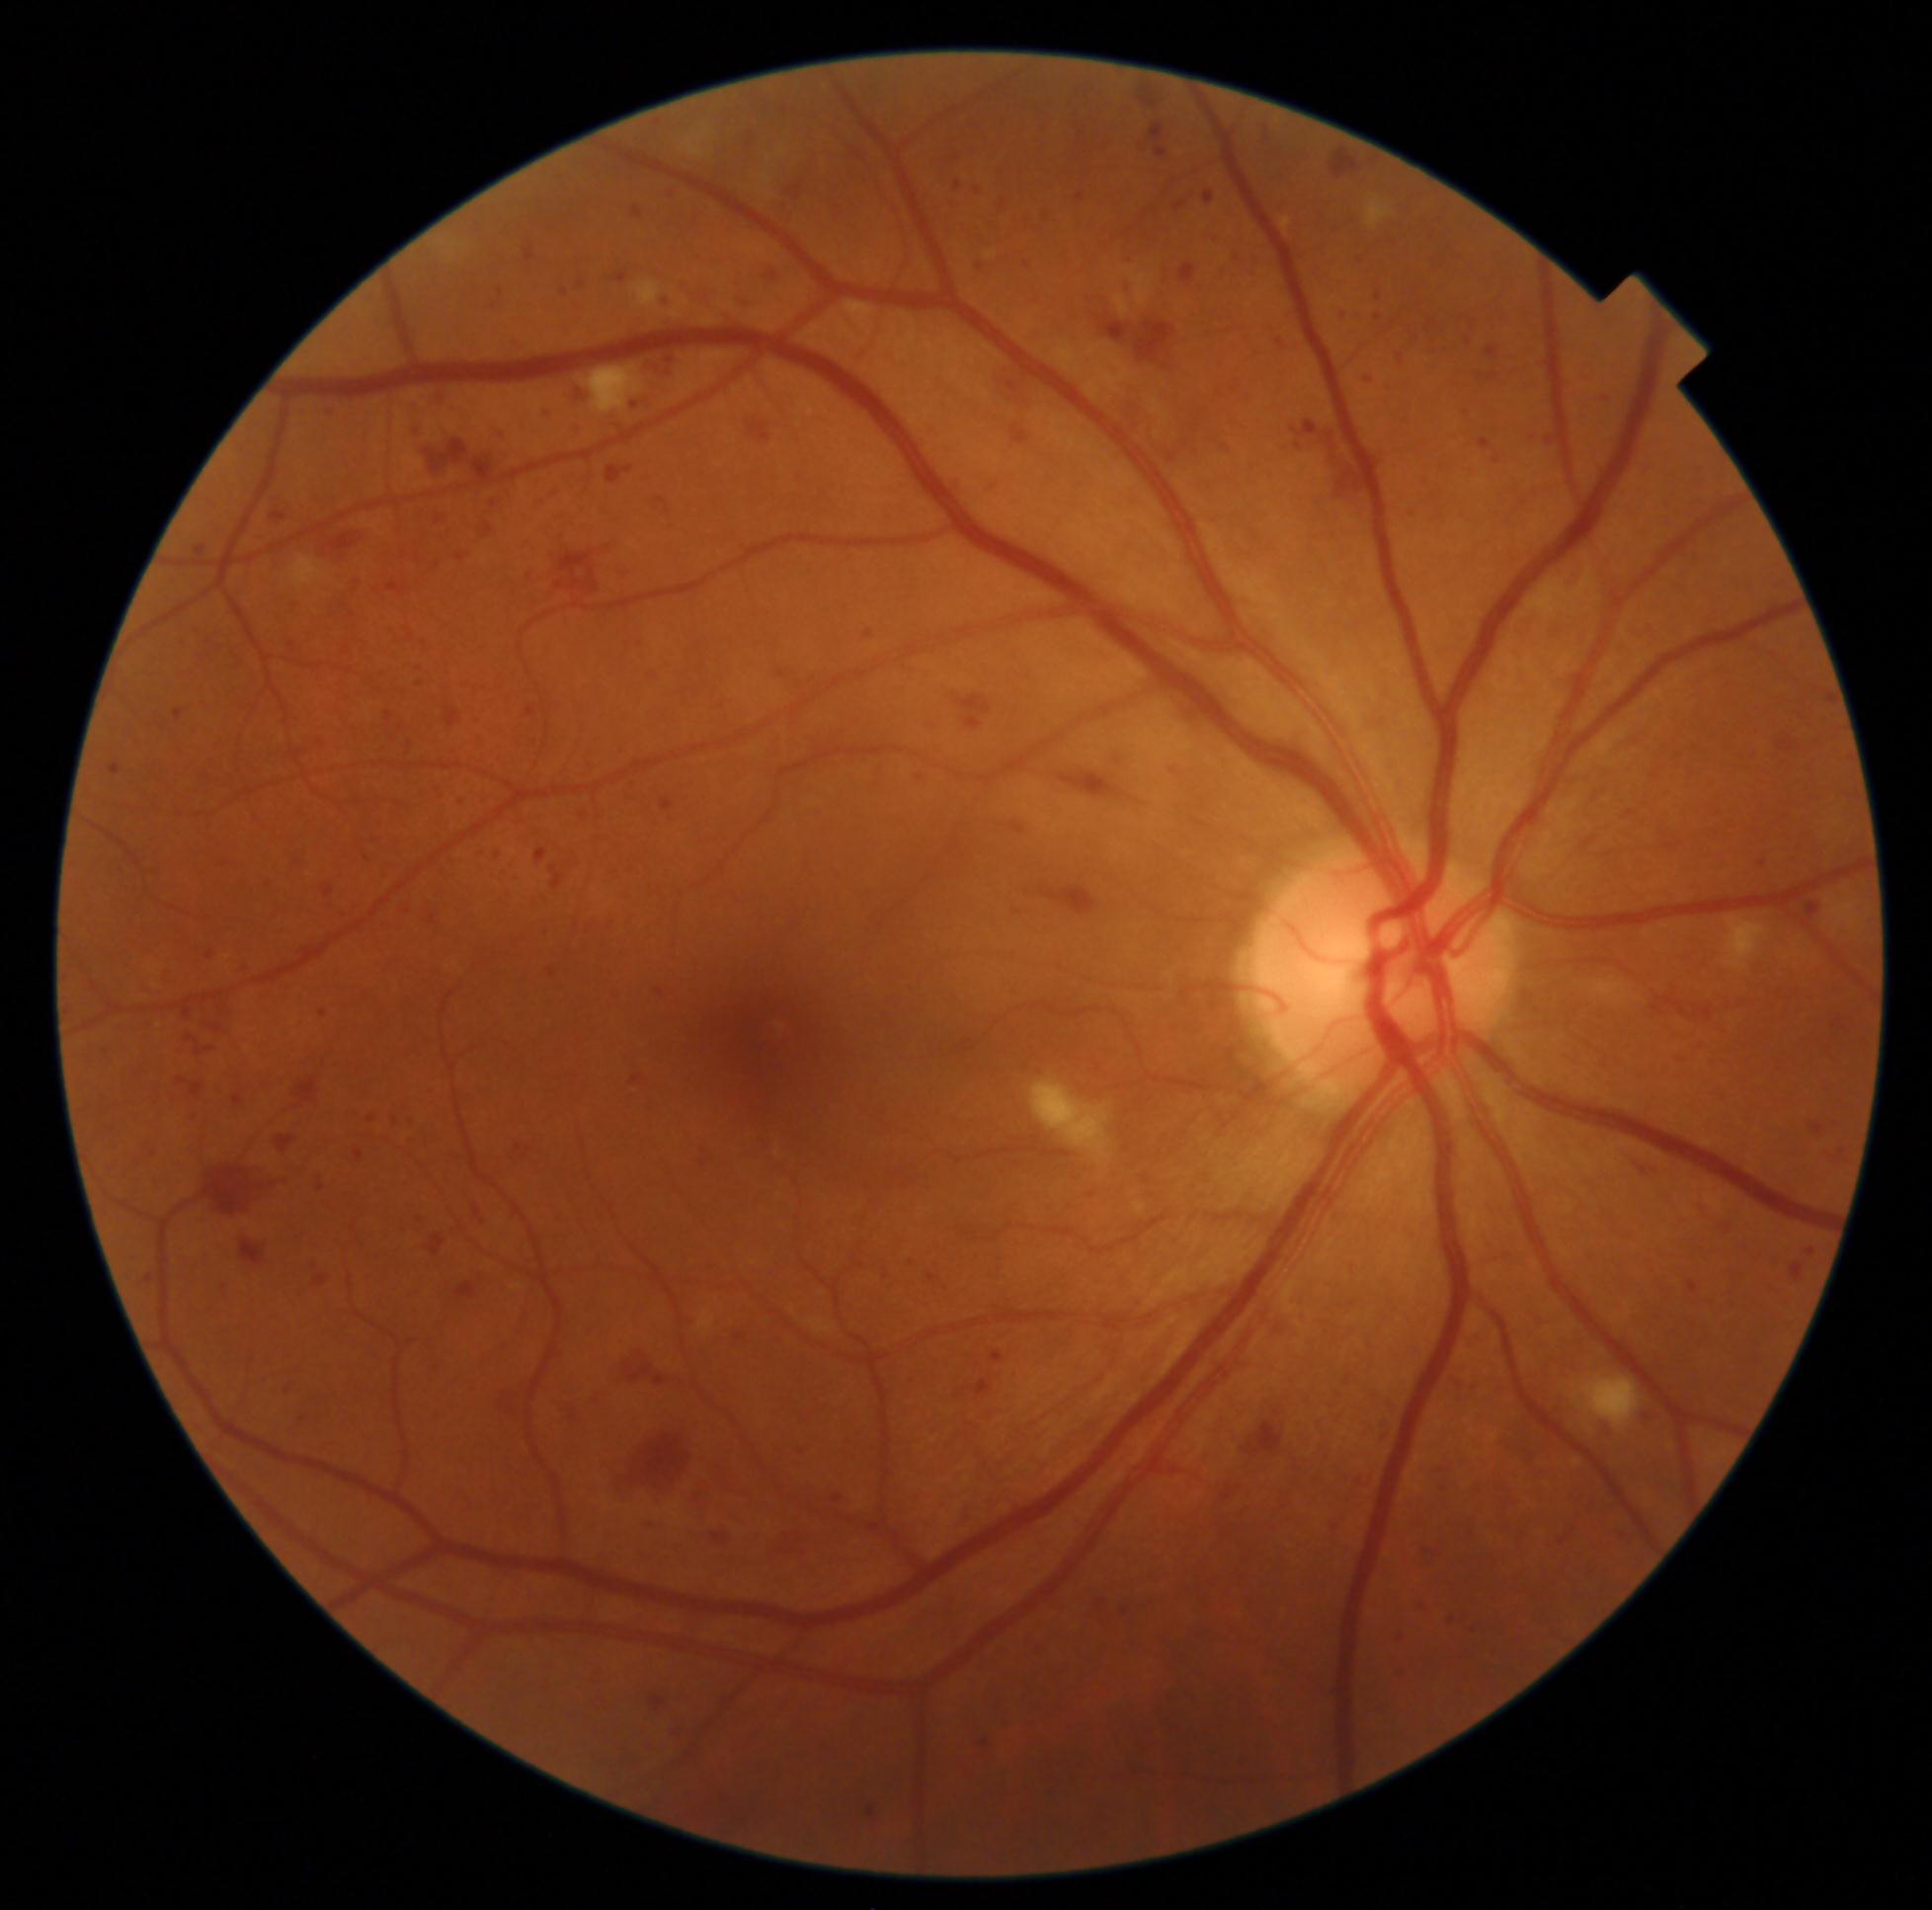 partial: true
dr_grade: 3
dr_grade_name: severe NPDR
lesions:
  he:
    - rect(1352, 255, 1366, 266)
    - rect(1466, 319, 1479, 337)
    - rect(1602, 317, 1618, 333)
    - rect(993, 372, 1068, 451)
    - rect(279, 983, 294, 1000)
    - rect(1353, 1470, 1373, 1491)
    - rect(1175, 704, 1203, 740)
    - rect(526, 708, 537, 717)
    - rect(1059, 772, 1127, 799)
    - rect(429, 781, 446, 803)
    - rect(405, 910, 413, 915)
    - rect(193, 626, 210, 637)
    - rect(1012, 824, 1025, 835)
    - rect(1161, 451, 1180, 467)
    - rect(1389, 1662, 1410, 1686)
    - rect(396, 1226, 411, 1237)
    - rect(1565, 775, 1591, 788)
    - rect(429, 915, 436, 923)
    - rect(771, 662, 800, 683)
  he_small:
    - (1090,1196)